45-degree field of view. Retinal fundus photograph. 2212 x 1659 pixels — 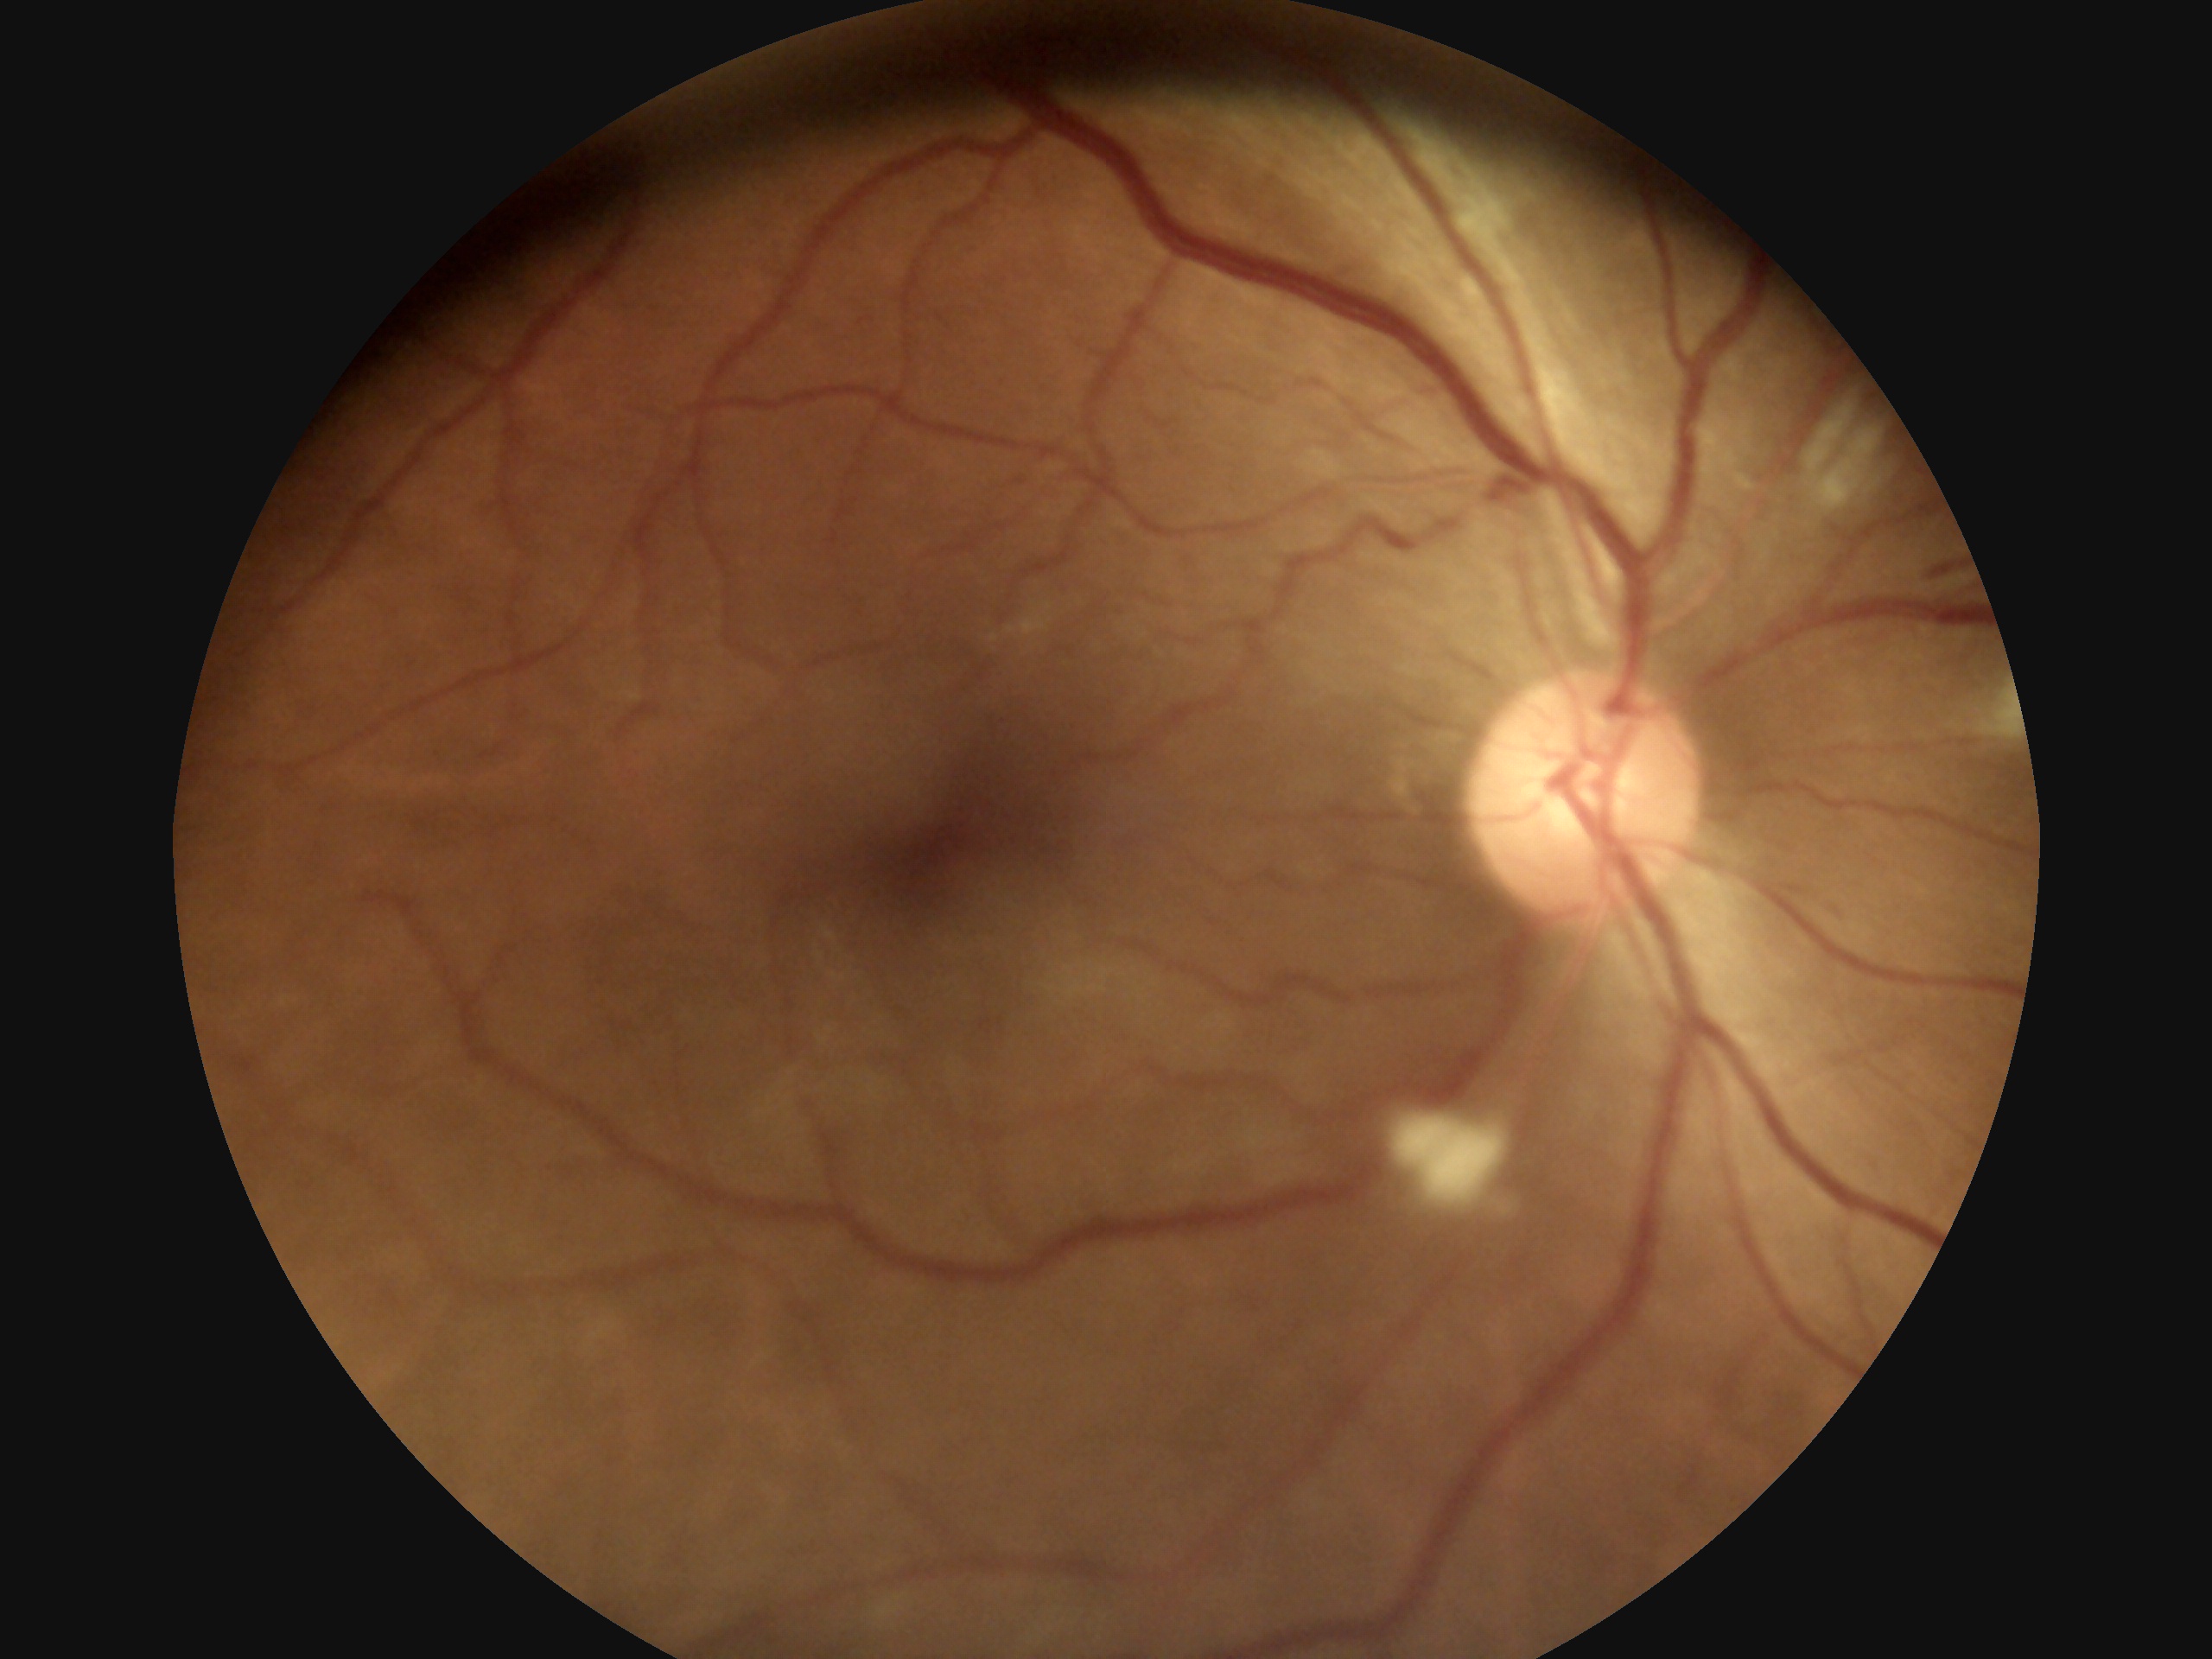

The retinopathy is classified as non-proliferative diabetic retinopathy. Retinopathy: grade 2 (moderate NPDR).